Pediatric wide-field fundus photograph.
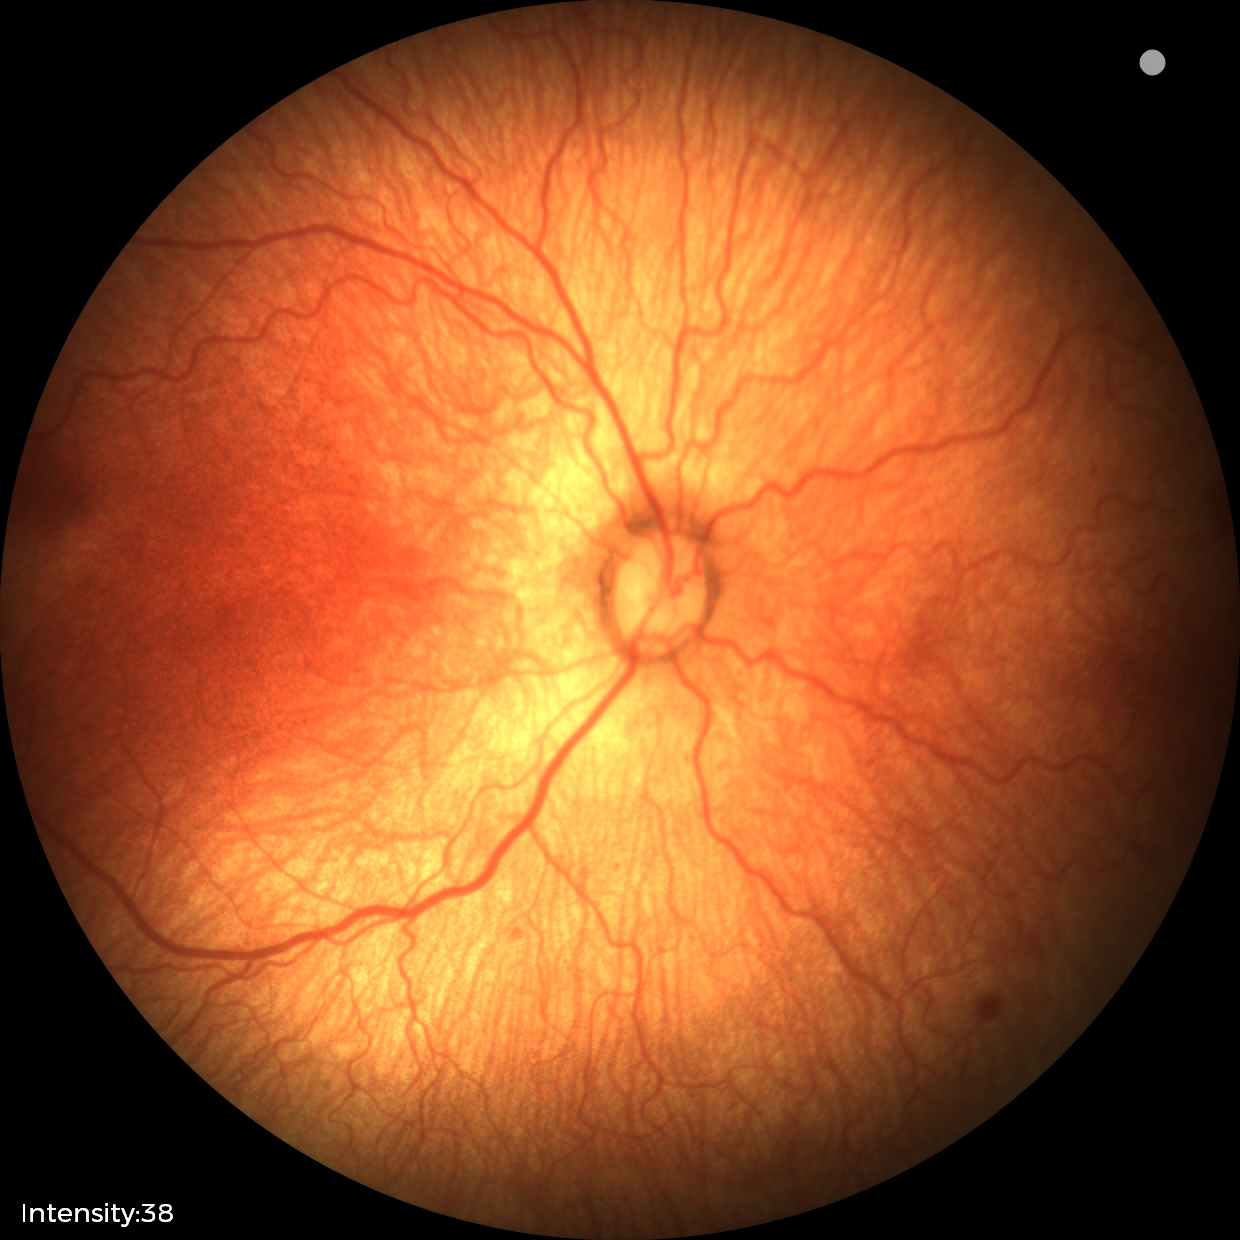 Screening diagnosis = retinopathy of prematurity stage 1 | plus disease = absent.